Non-mydriatic fundus camera — 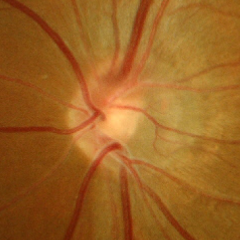
Optic disc photograph demonstrating early glaucoma.